Modified Davis classification · 45 degree fundus photograph — 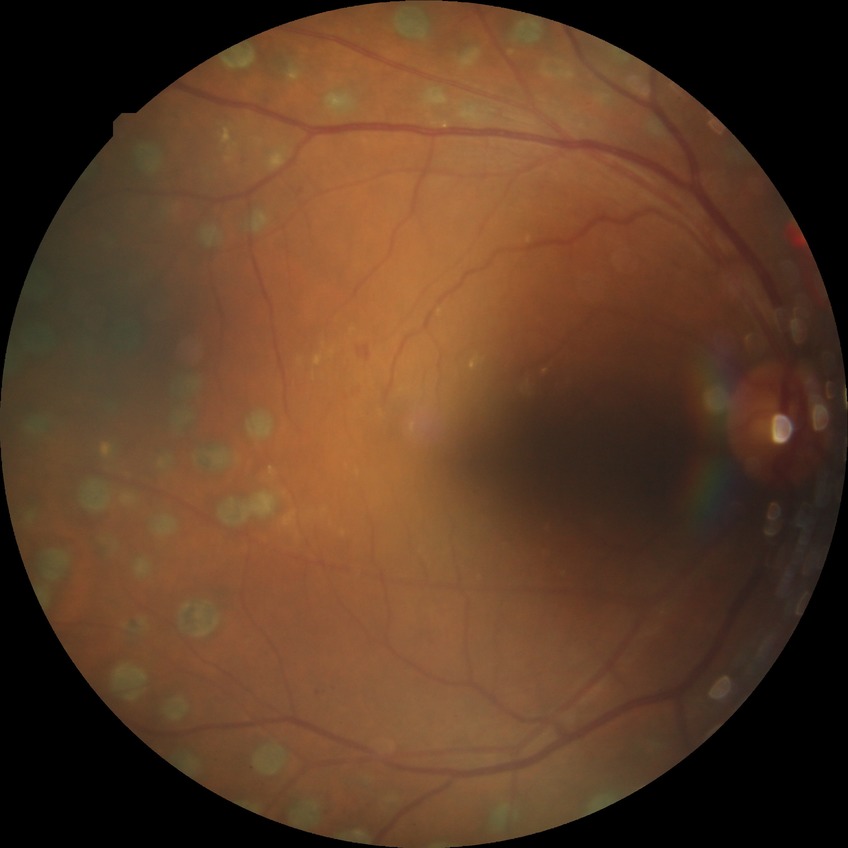 Diabetic retinopathy (DR) is PDR (proliferative diabetic retinopathy).